Color fundus image, FOV: 45 degrees.
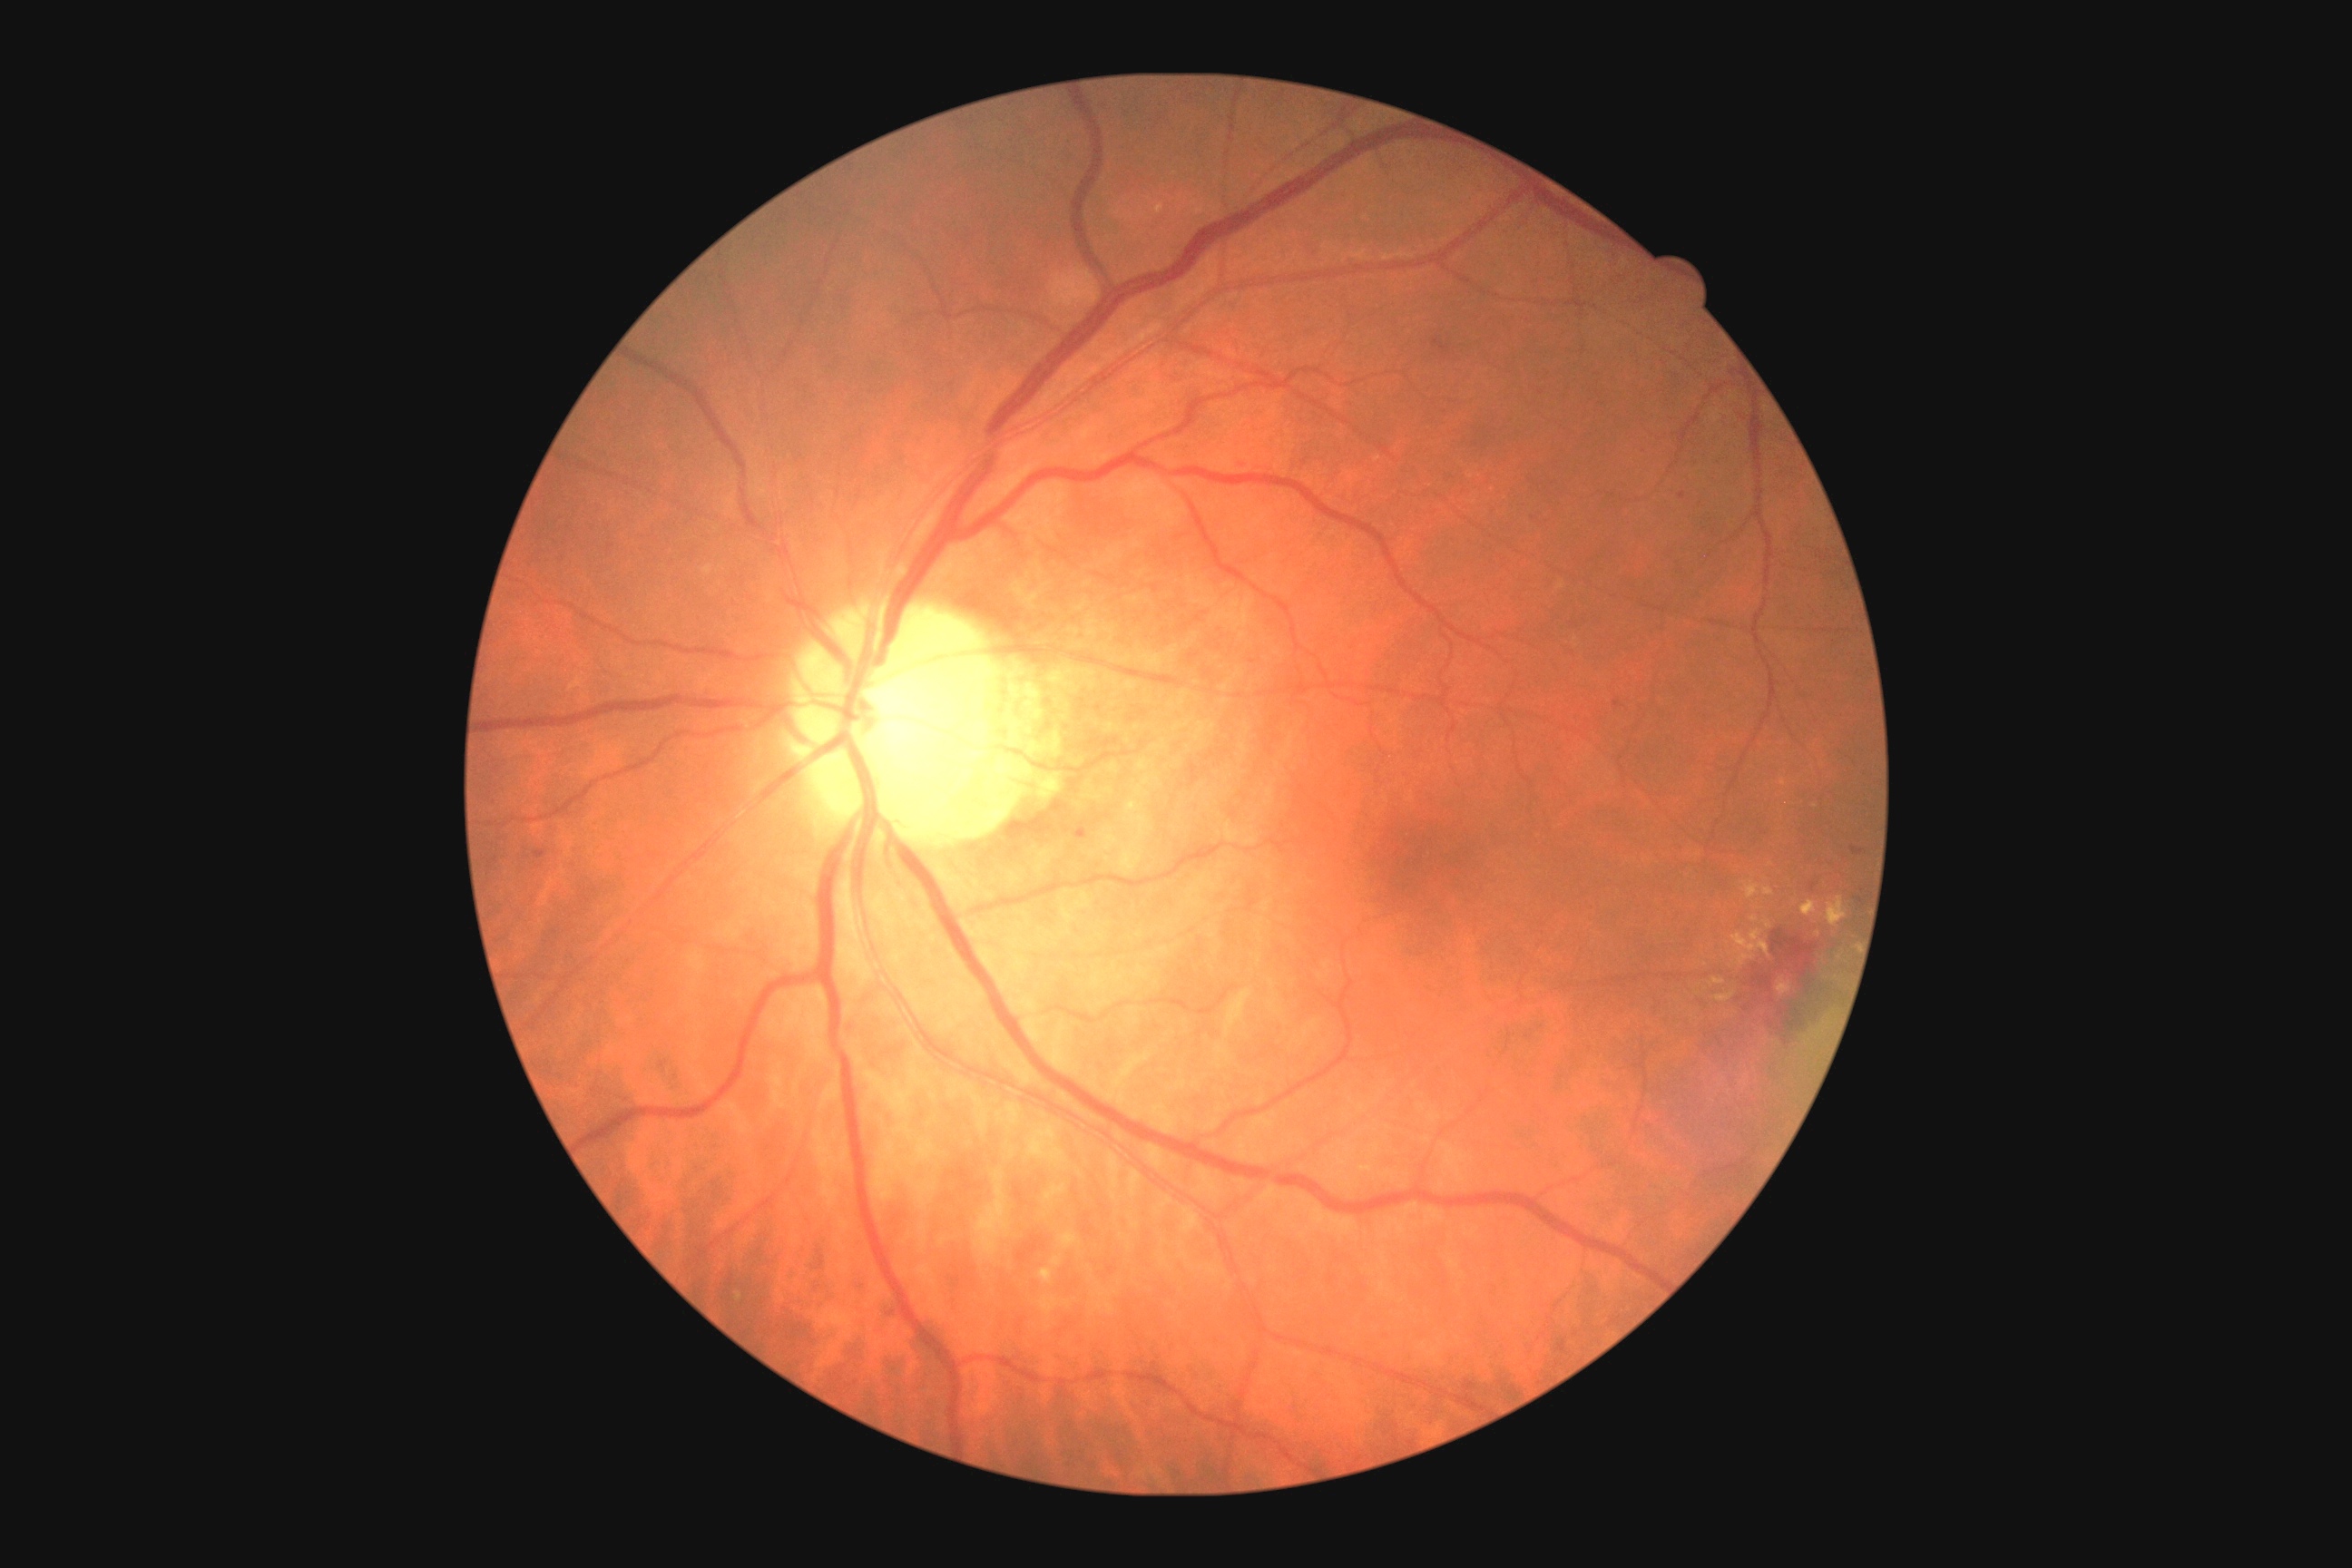
DR stage is moderate NPDR (grade 2).
DR class: non-proliferative diabetic retinopathy.